Infant wide-field fundus photograph; camera: Natus RetCam Envision (130° FOV)
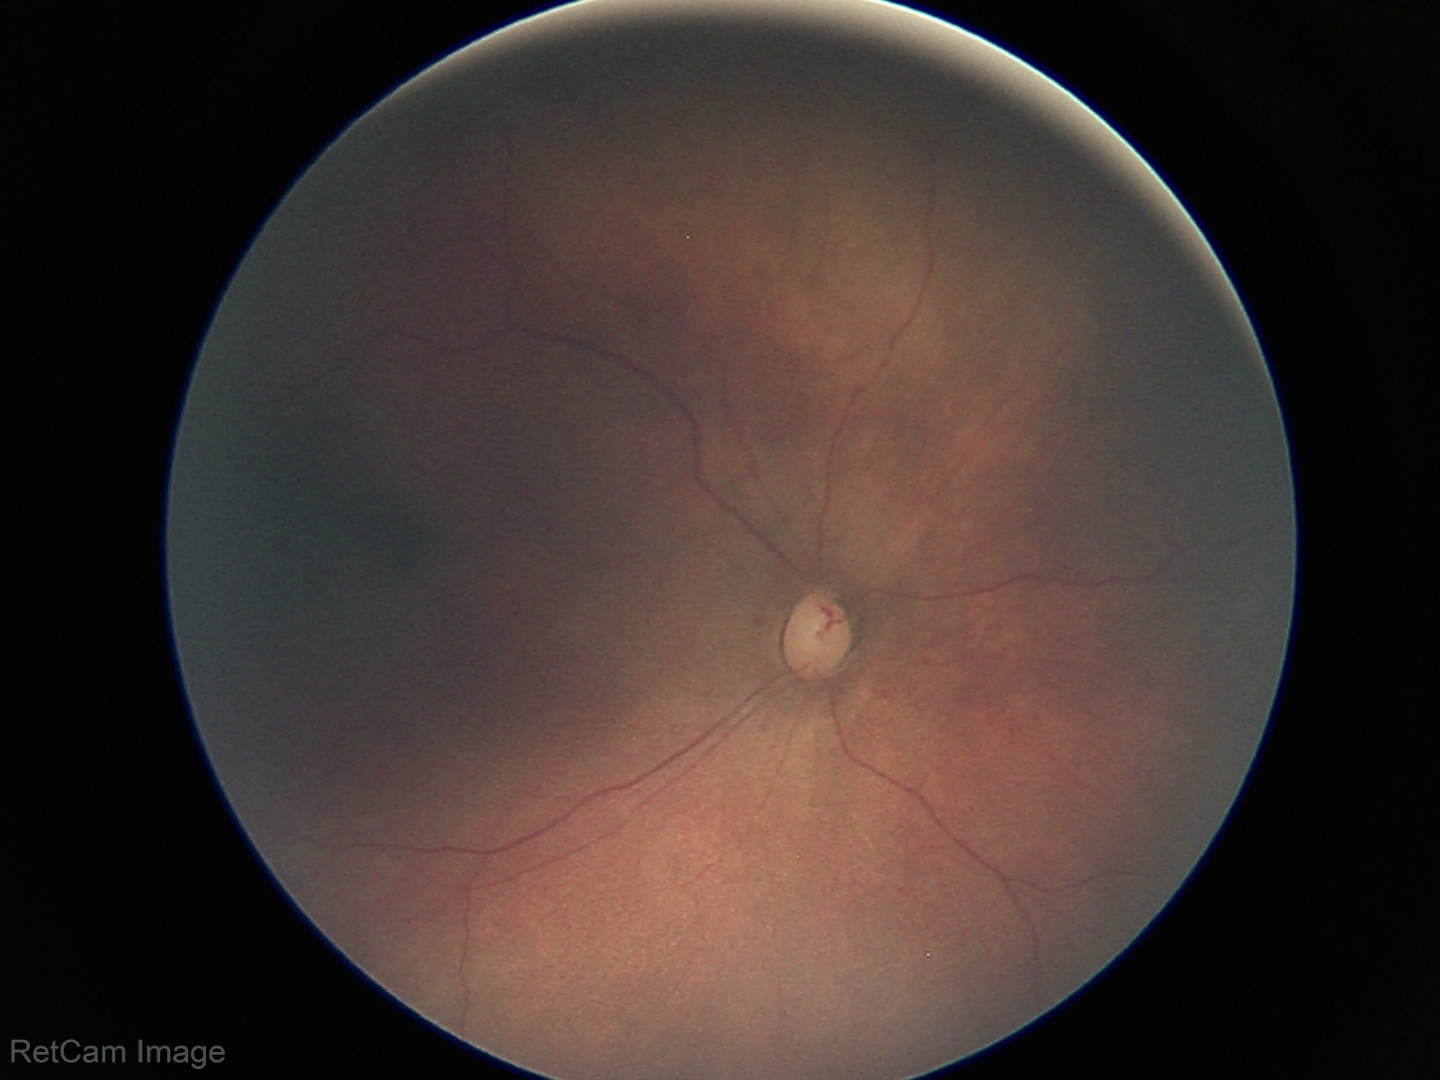
Screening examination with no abnormal retinal findings.